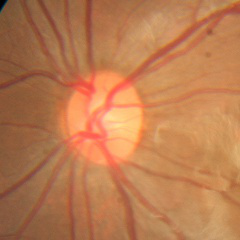

Glaucoma diagnosis: no glaucomatous findings.